Pediatric retinal photograph (wide-field).
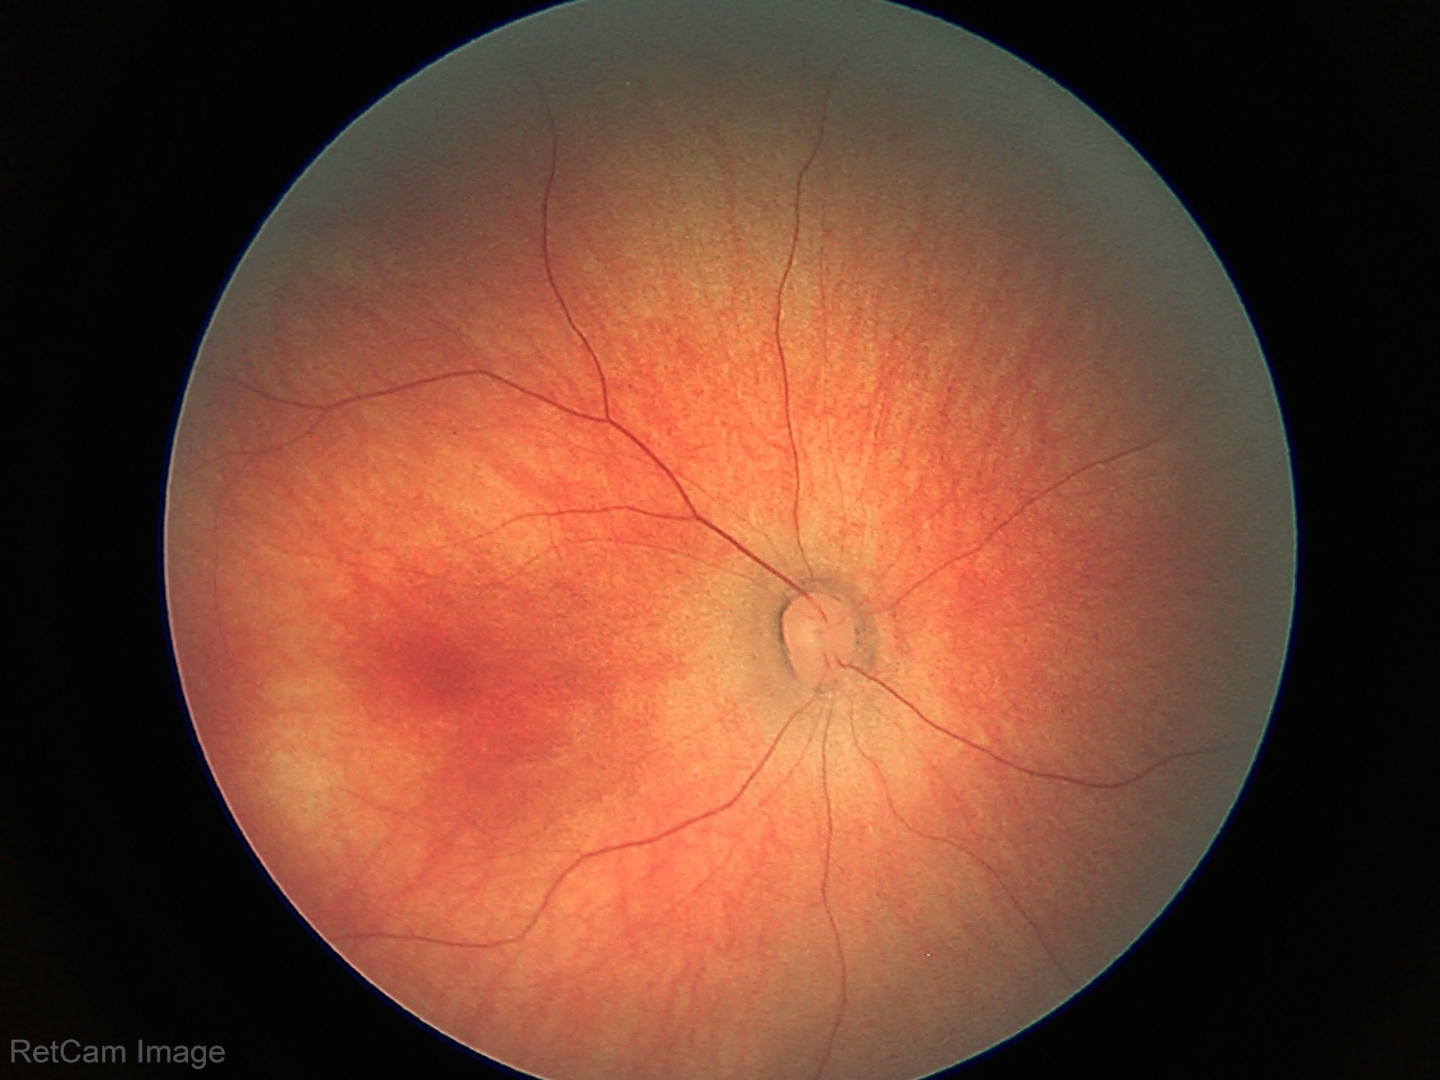 Screening: no abnormal retinal findings.